1924 x 1556 pixels · ultra-widefield (UWF) fundus image.
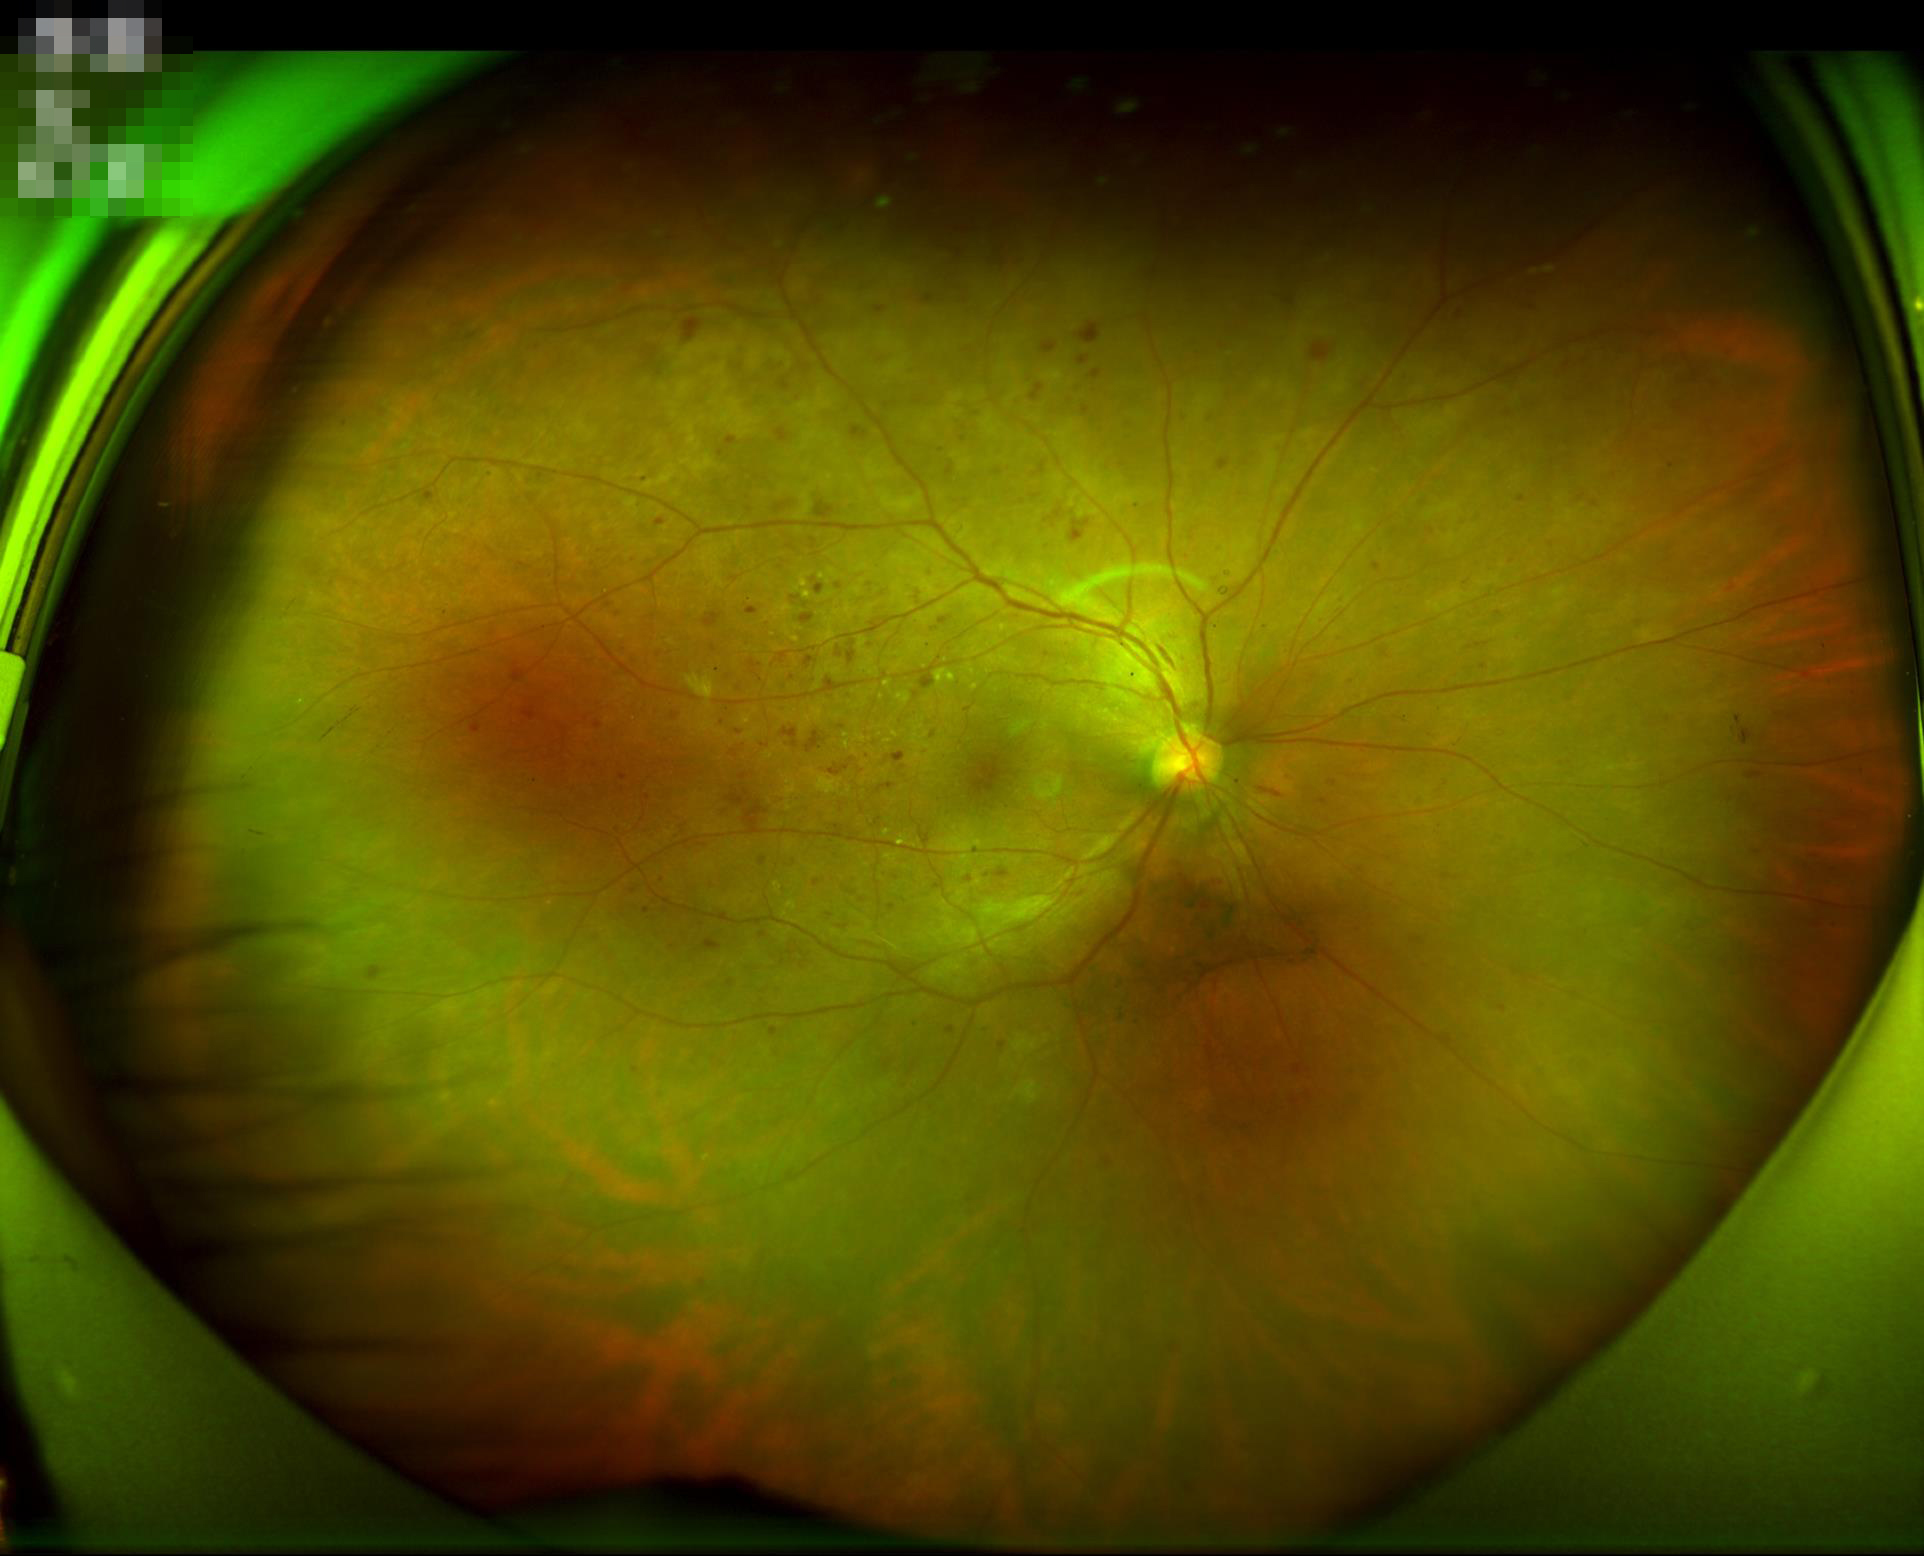

Quality assessment:
- sharpness: clear
- illumination: adequate
- contrast: adequate
- overall: adequate